1932x1916px · FOV: 45 degrees:
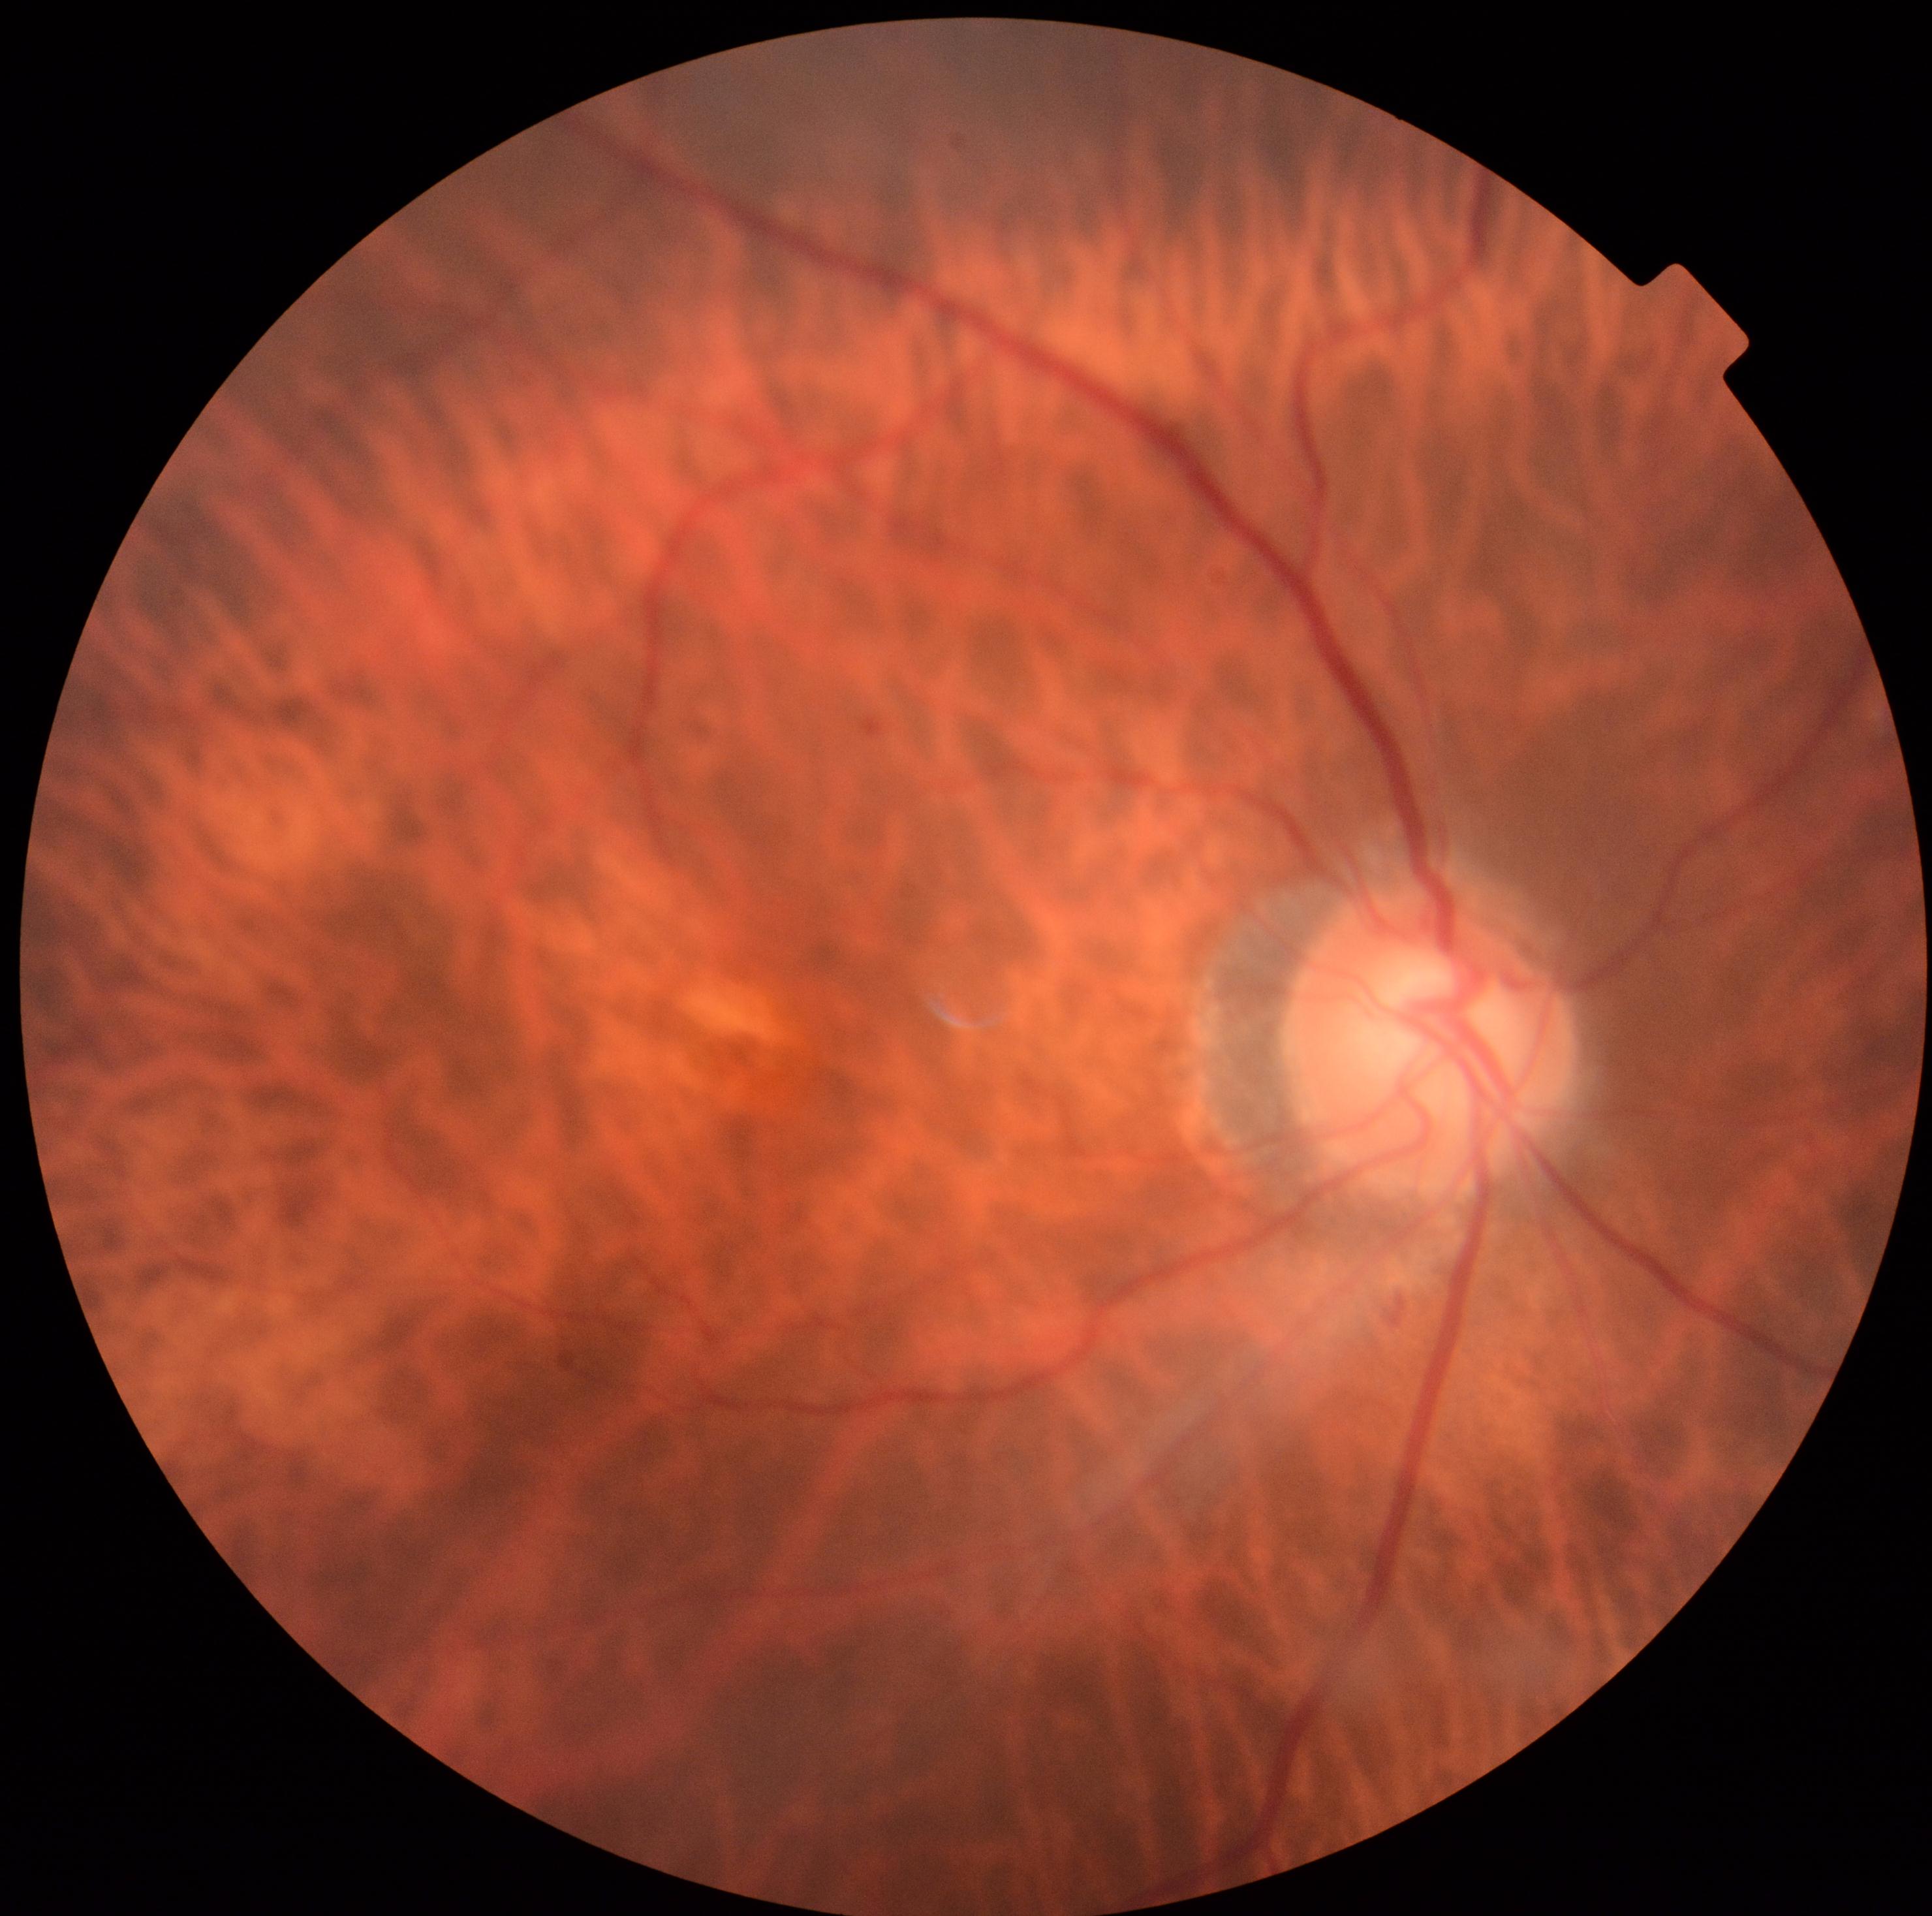

• DR stage — grade 1 (mild NPDR)